Without pupil dilation.
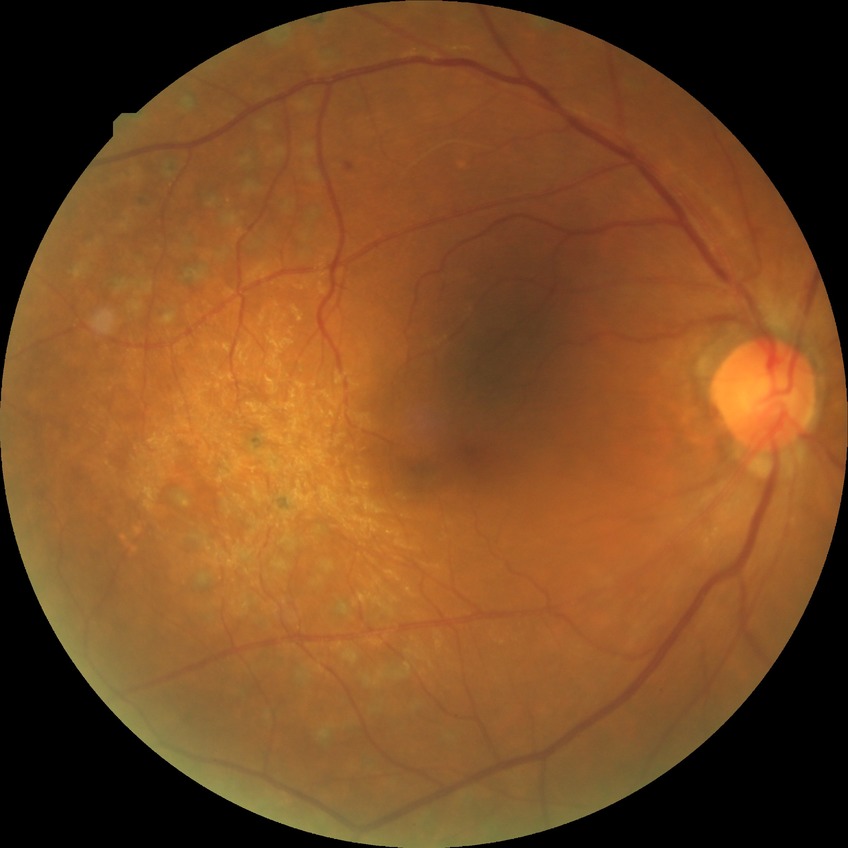
Davis DR grade: PDR.